Wide-field fundus photograph of an infant. 640x480
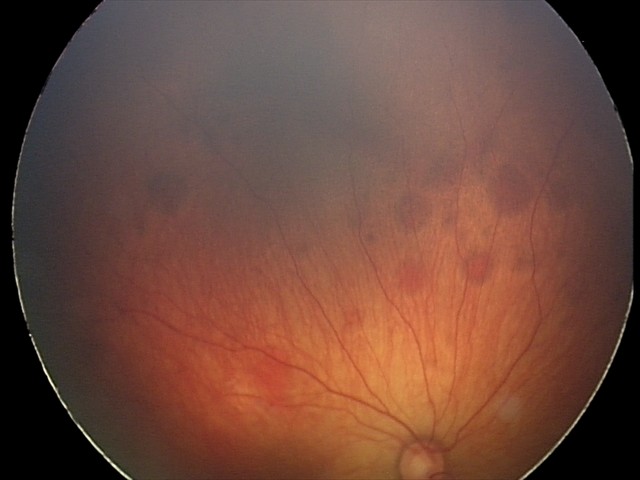 Diagnosis from this screening exam: retinal hemorrhages.